Infant wide-field retinal image — 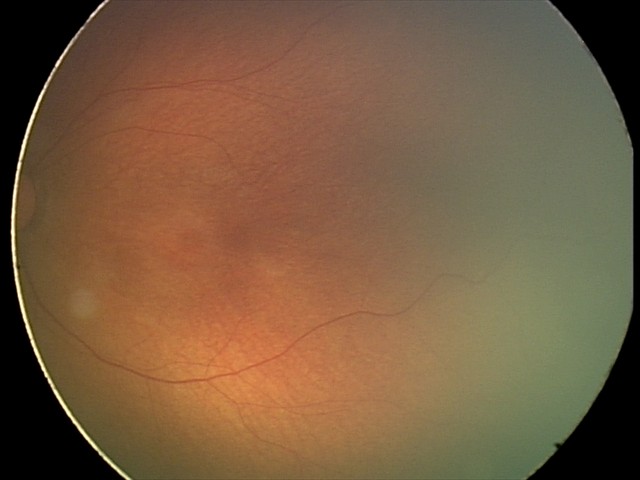
Screening diagnosis = physiological appearance.